2352 x 1568 pixels:
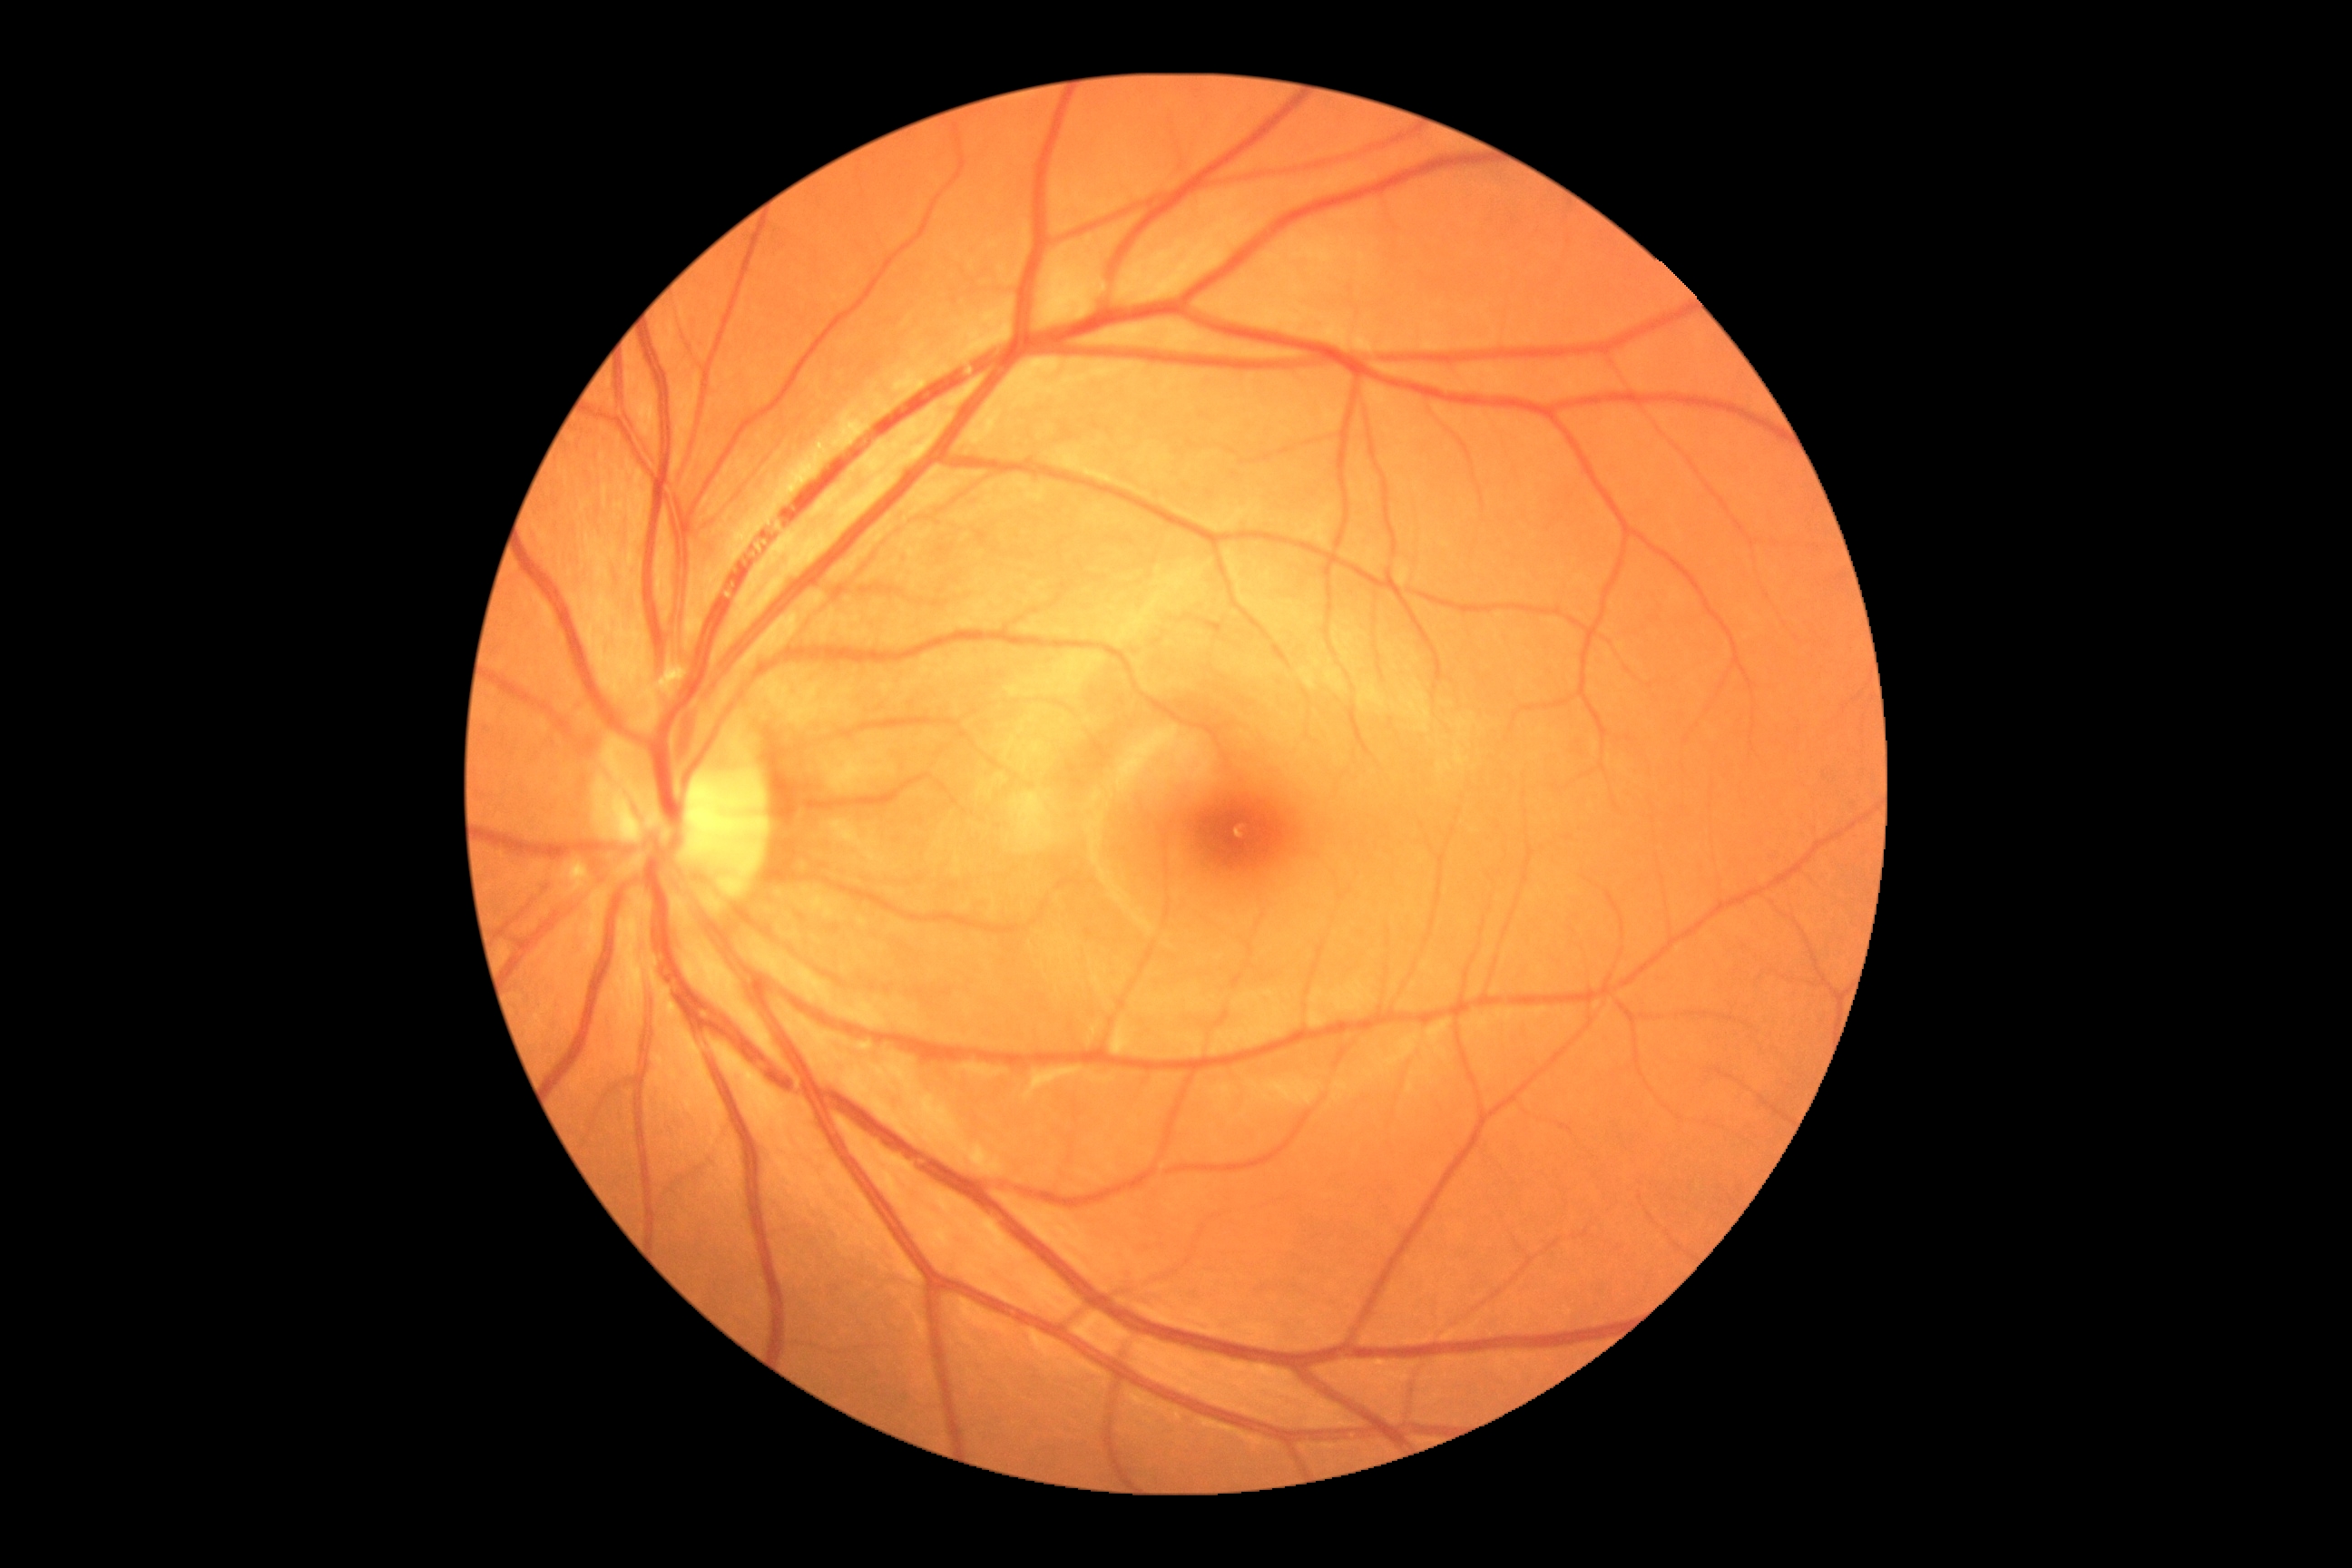 diabetic retinopathy (DR)=grade 0 (no apparent retinopathy).